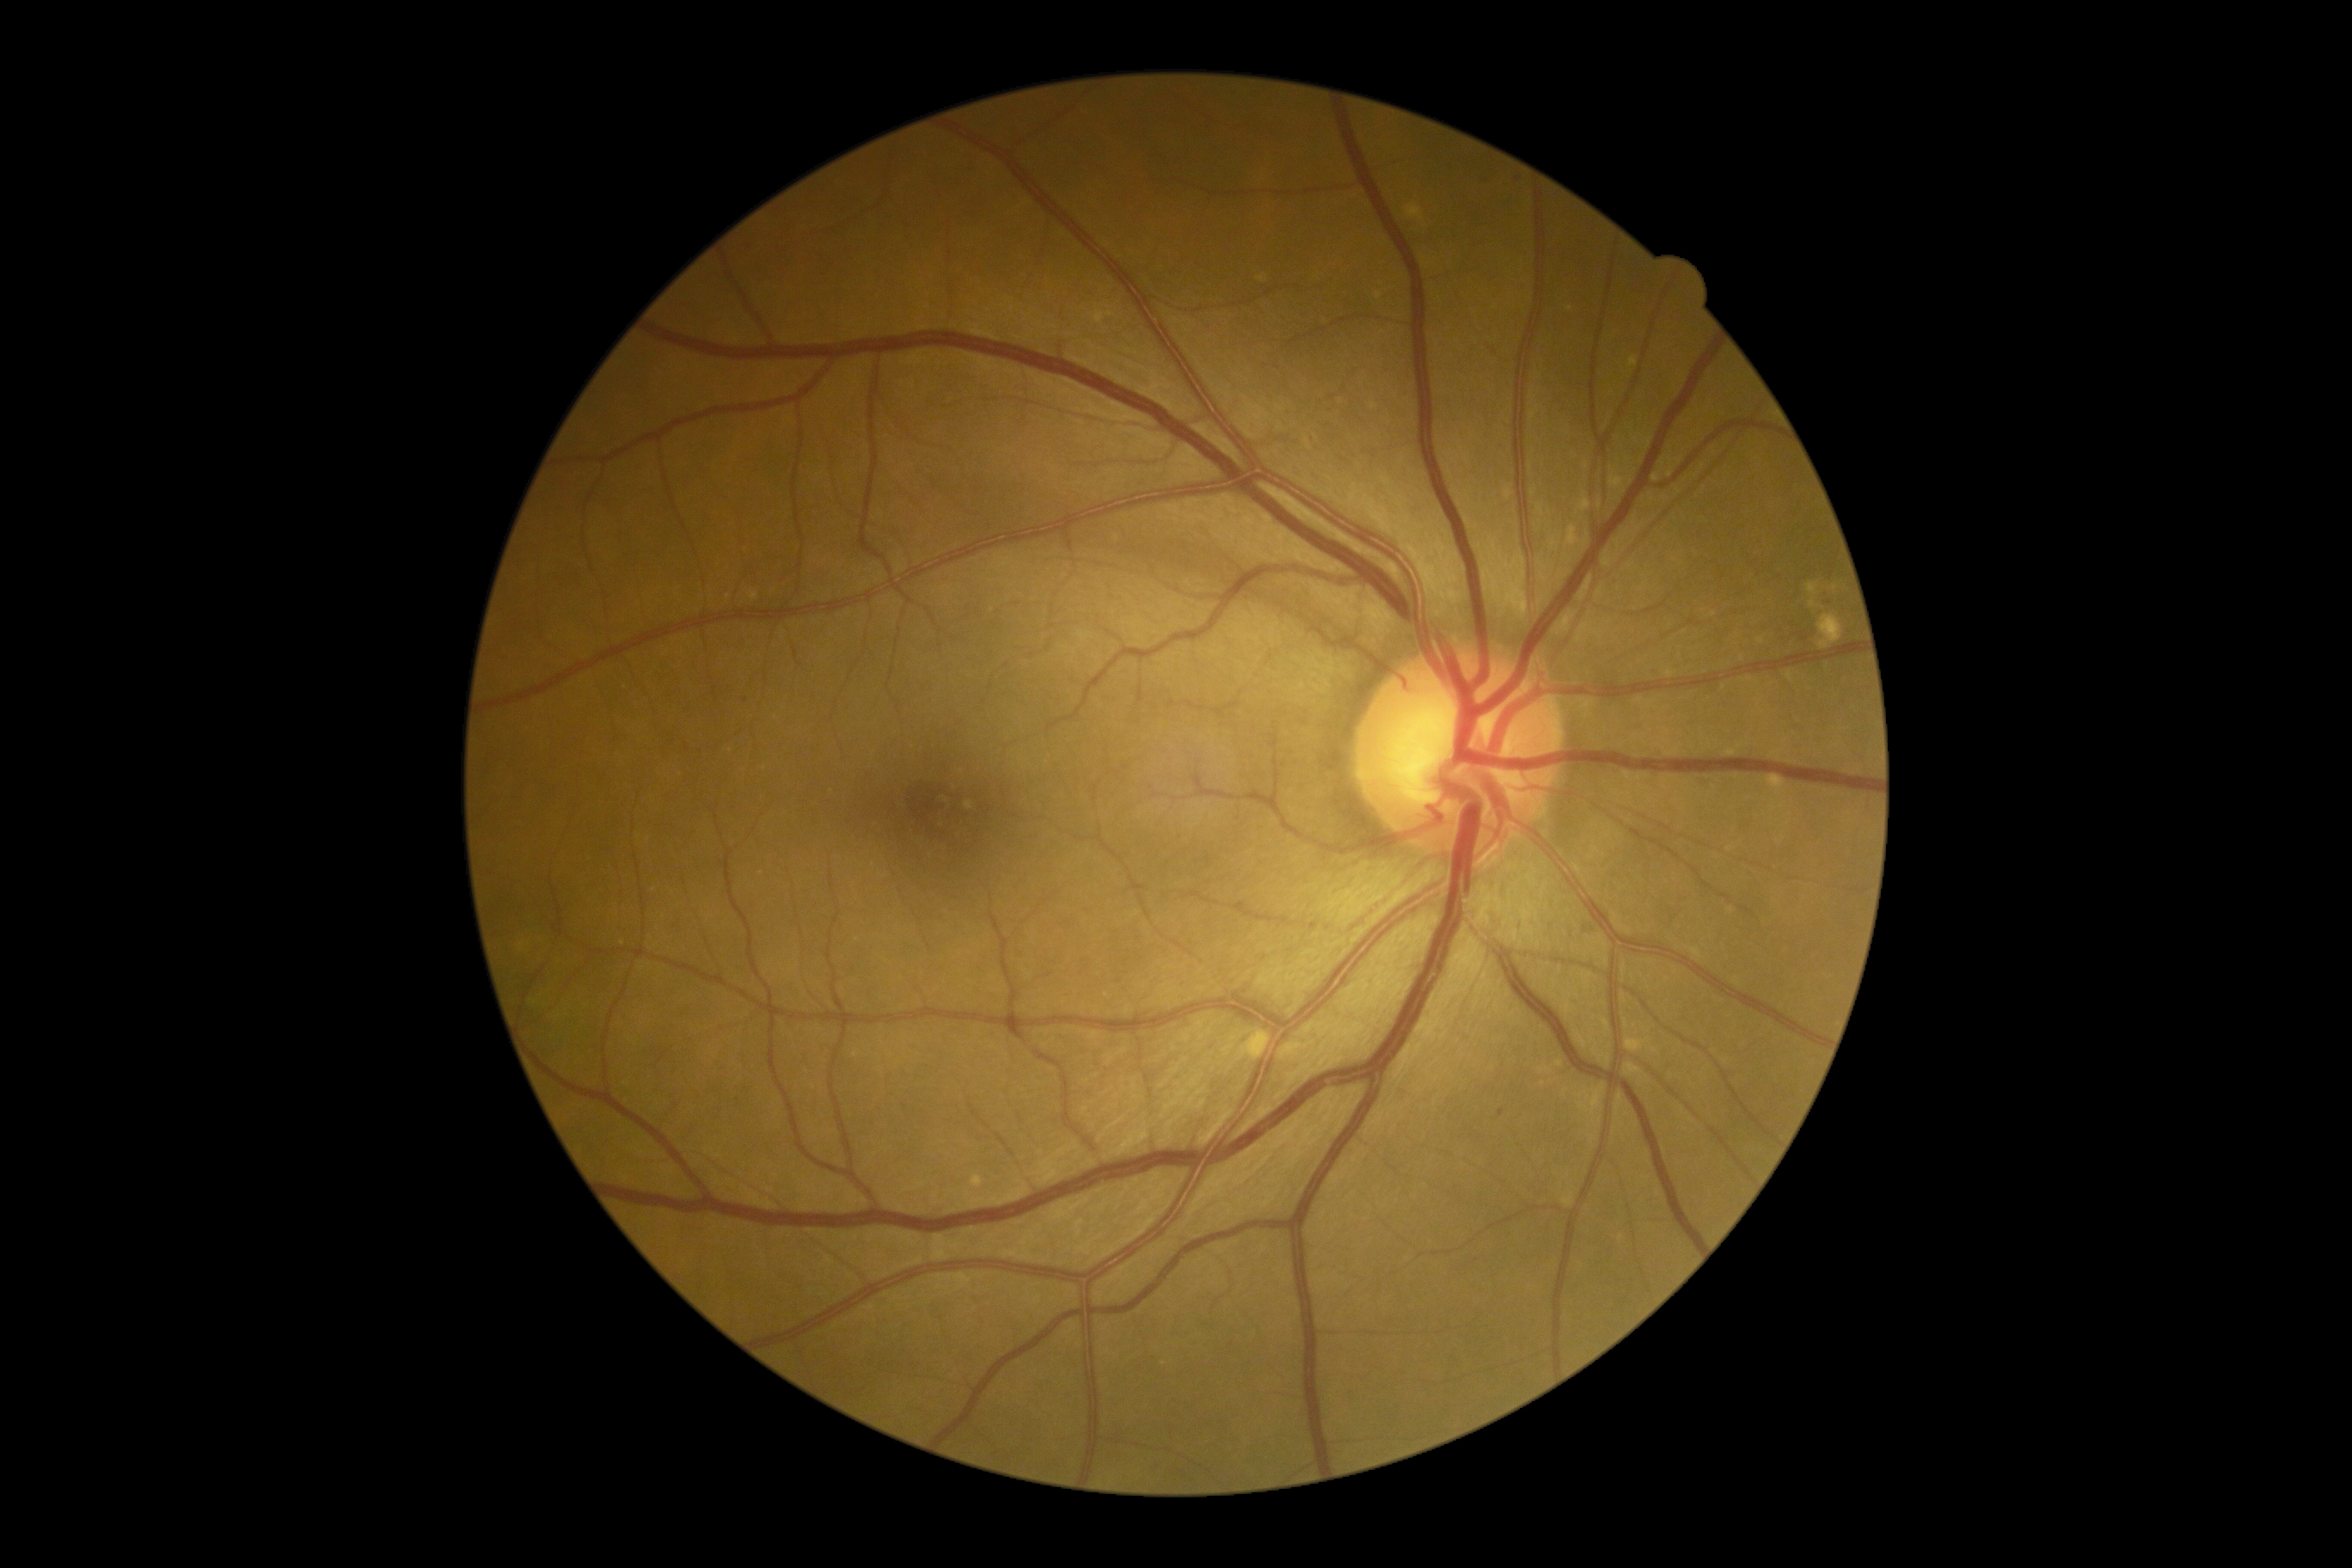
DR severity: 1.